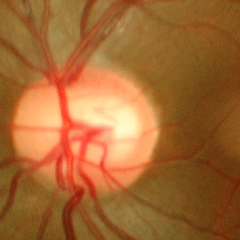
Glaucoma stage: early glaucoma.